1923 x 1932 pixels · FOV: 45 degrees — 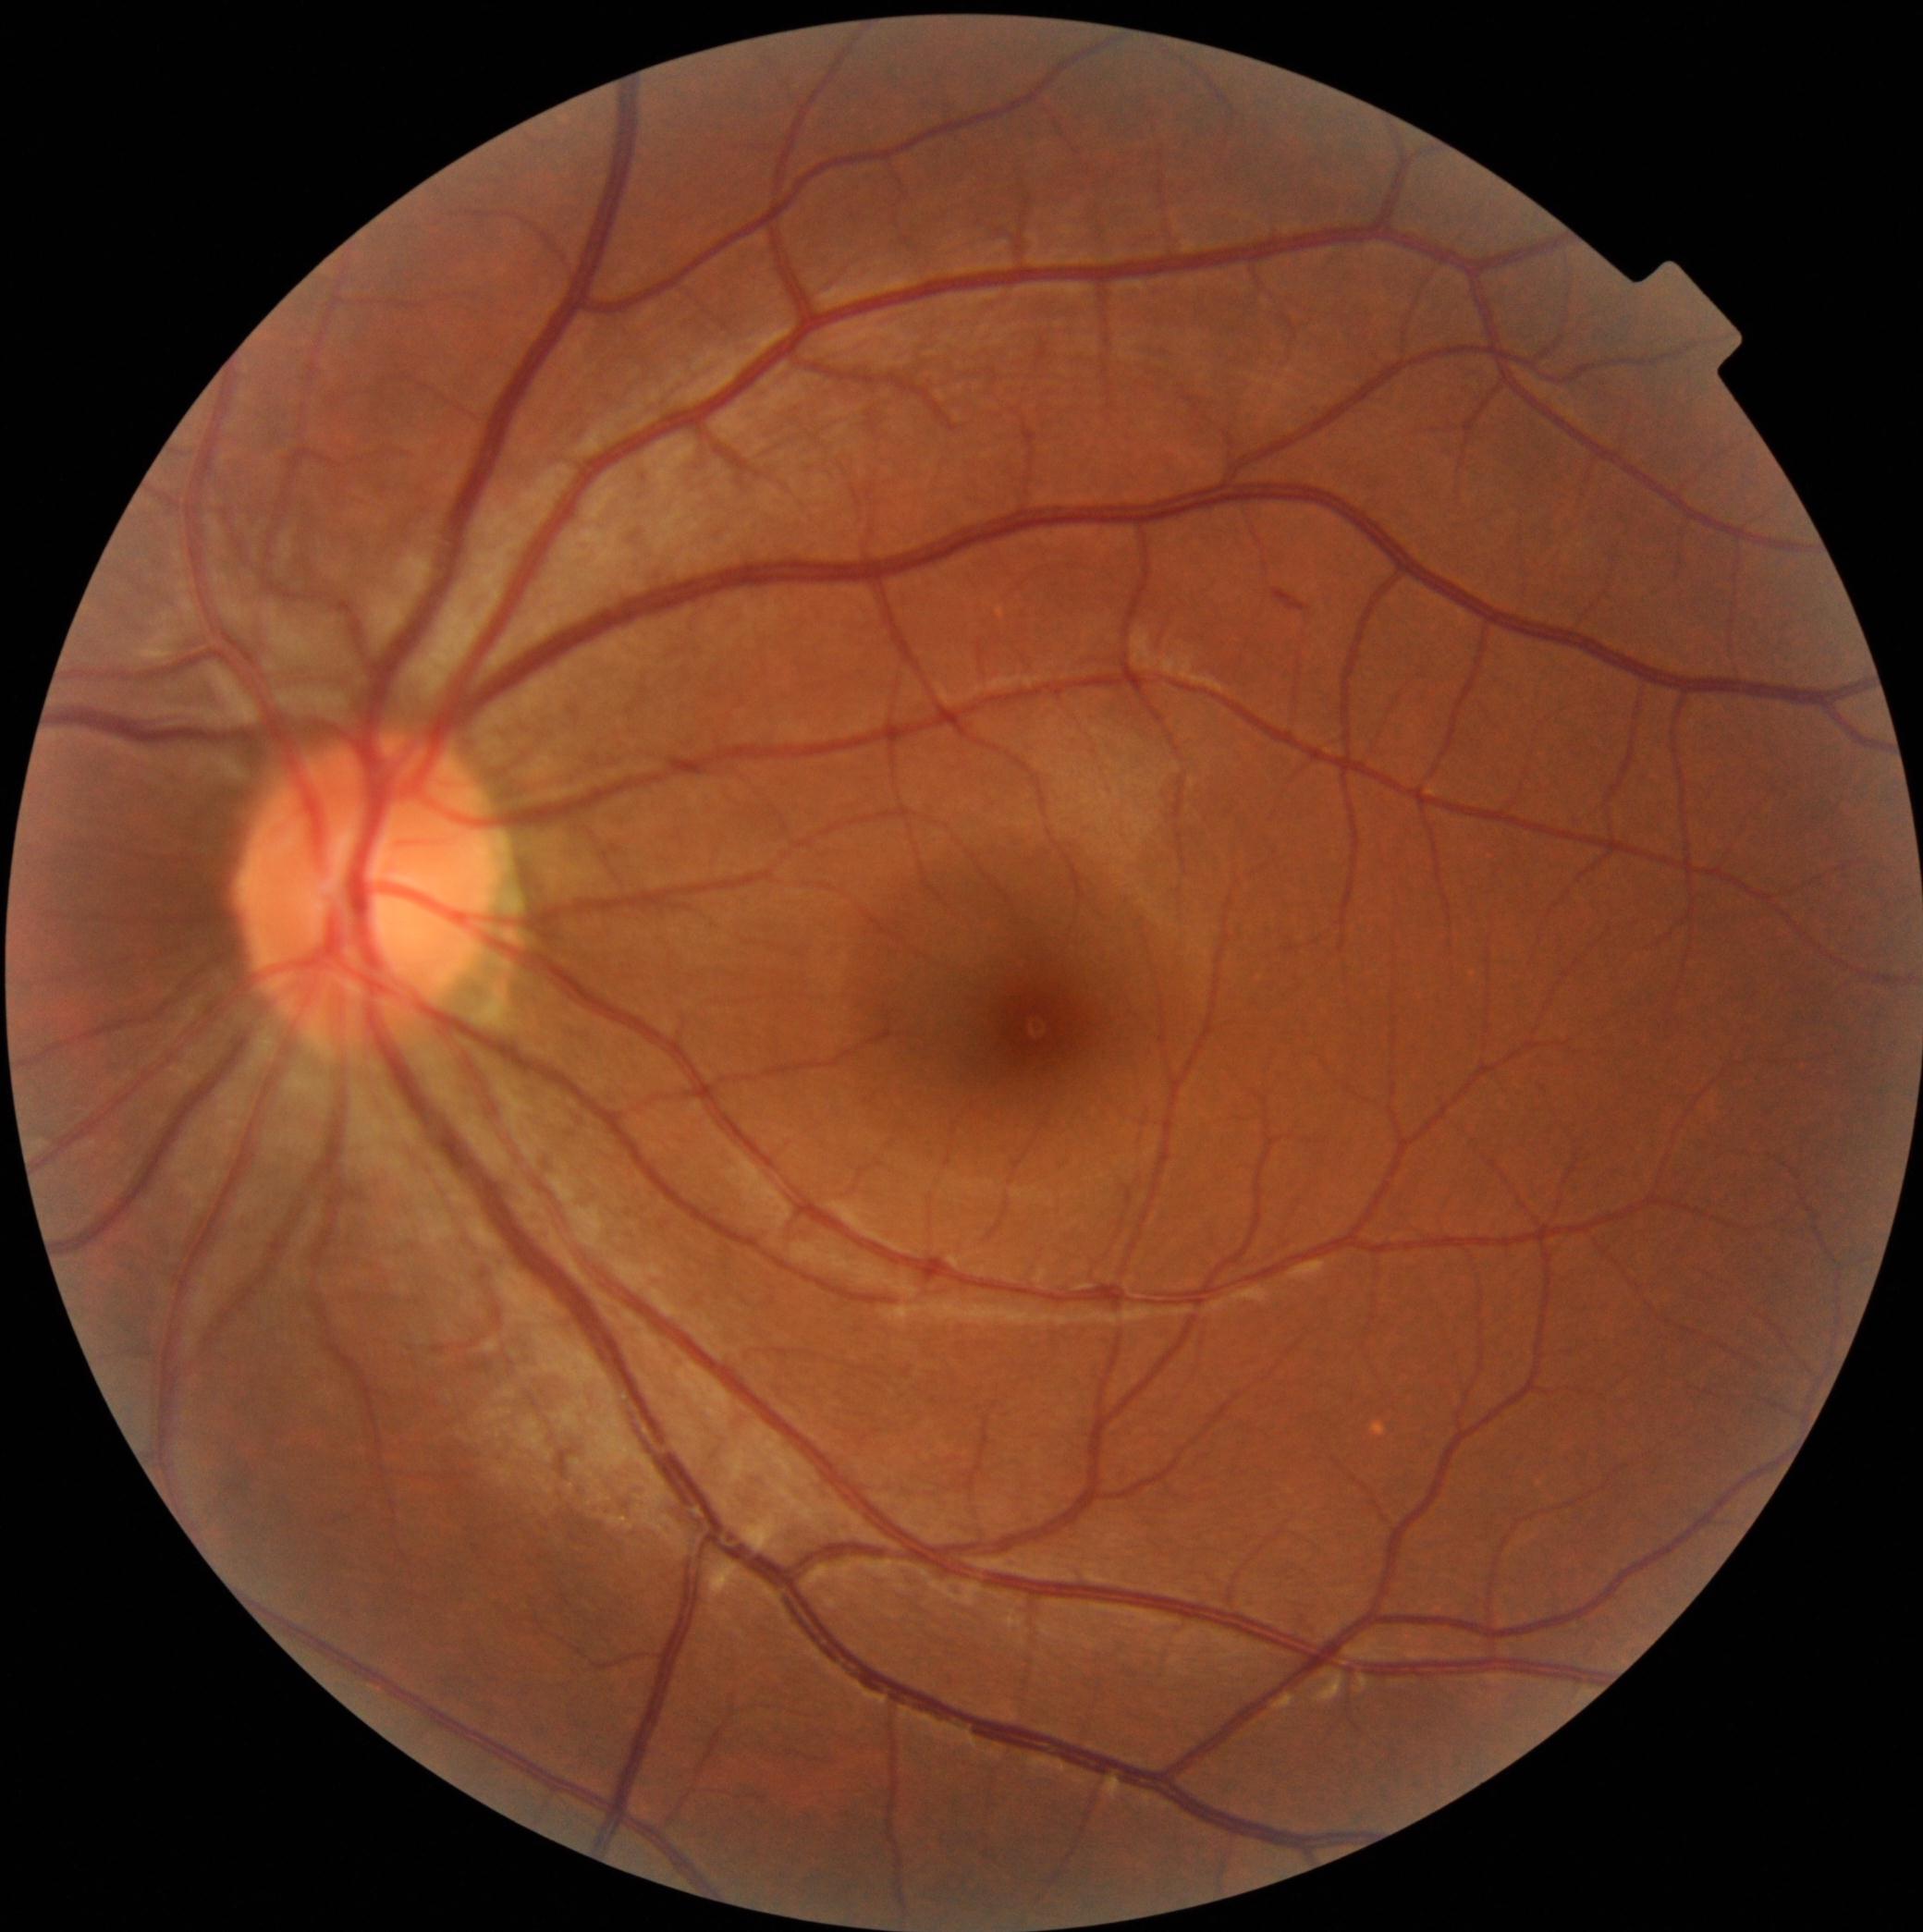

<lesions>
  <dr_grade>2</dr_grade>
  <he>region(1272, 589, 1310, 613)</he>
  <ex />
  <ma />
  <se />
</lesions>